45° field of view
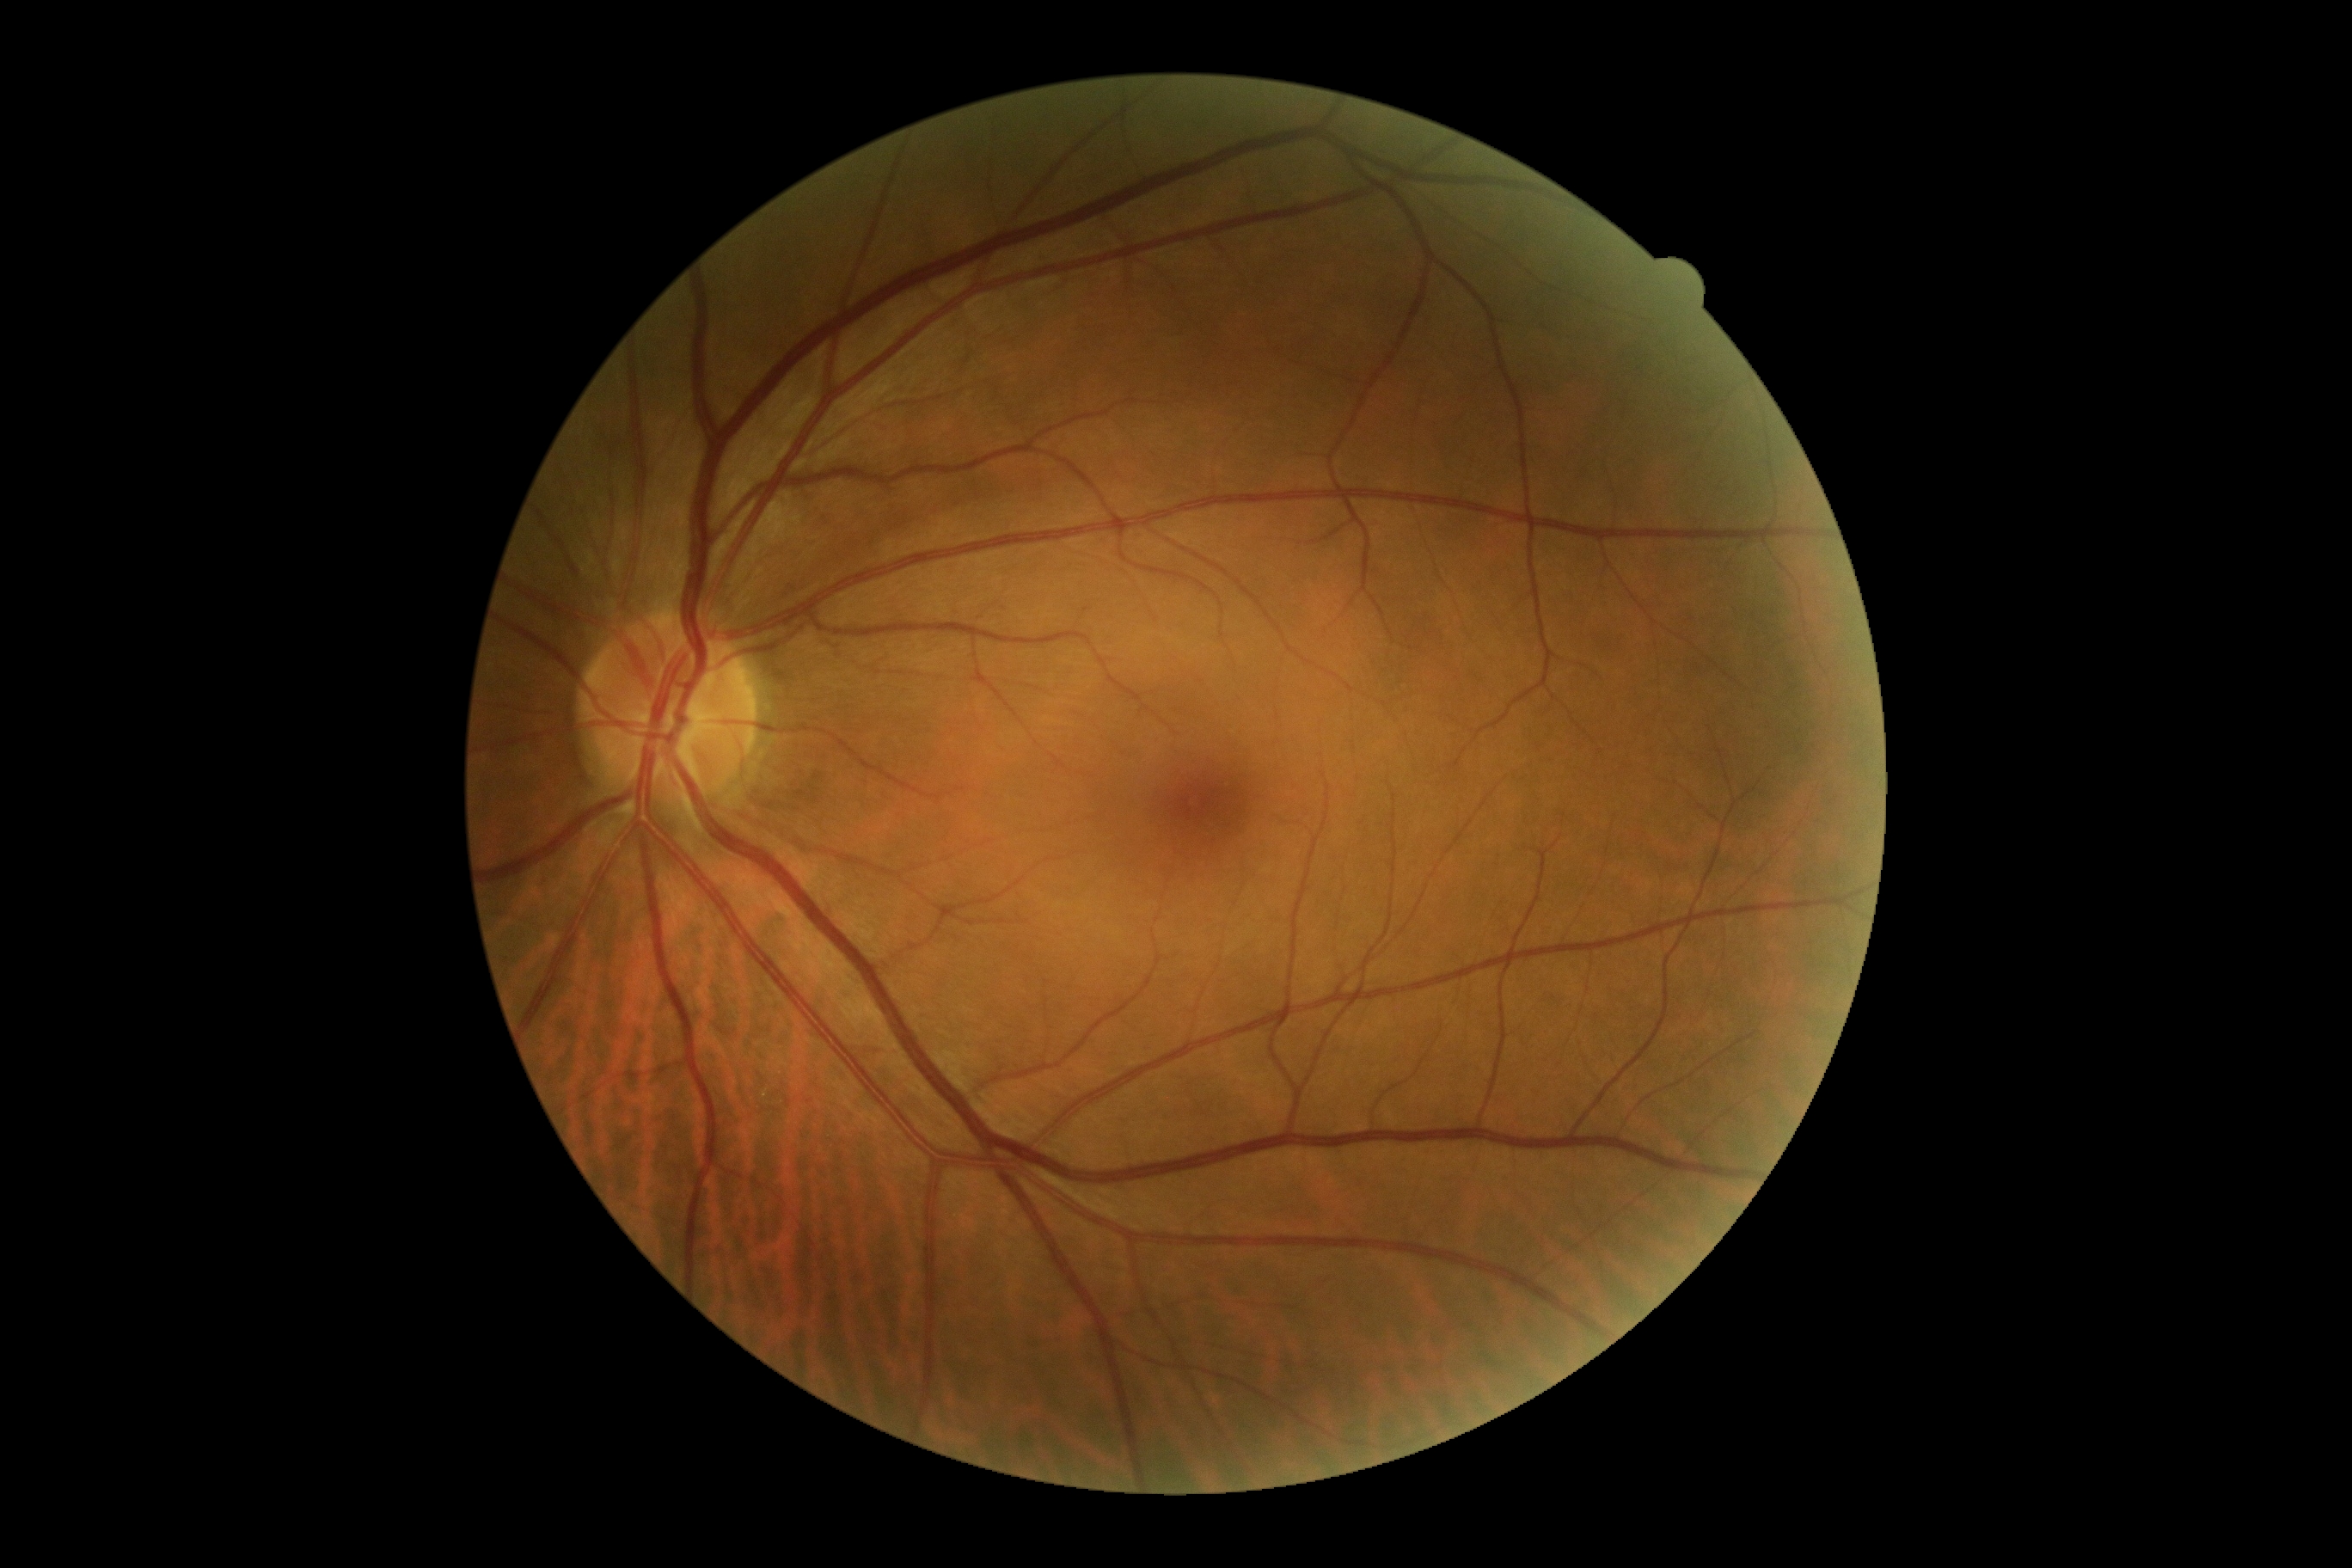
* DR impression: no apparent DR
* DR stage: 0